Wide-field fundus photograph of an infant: 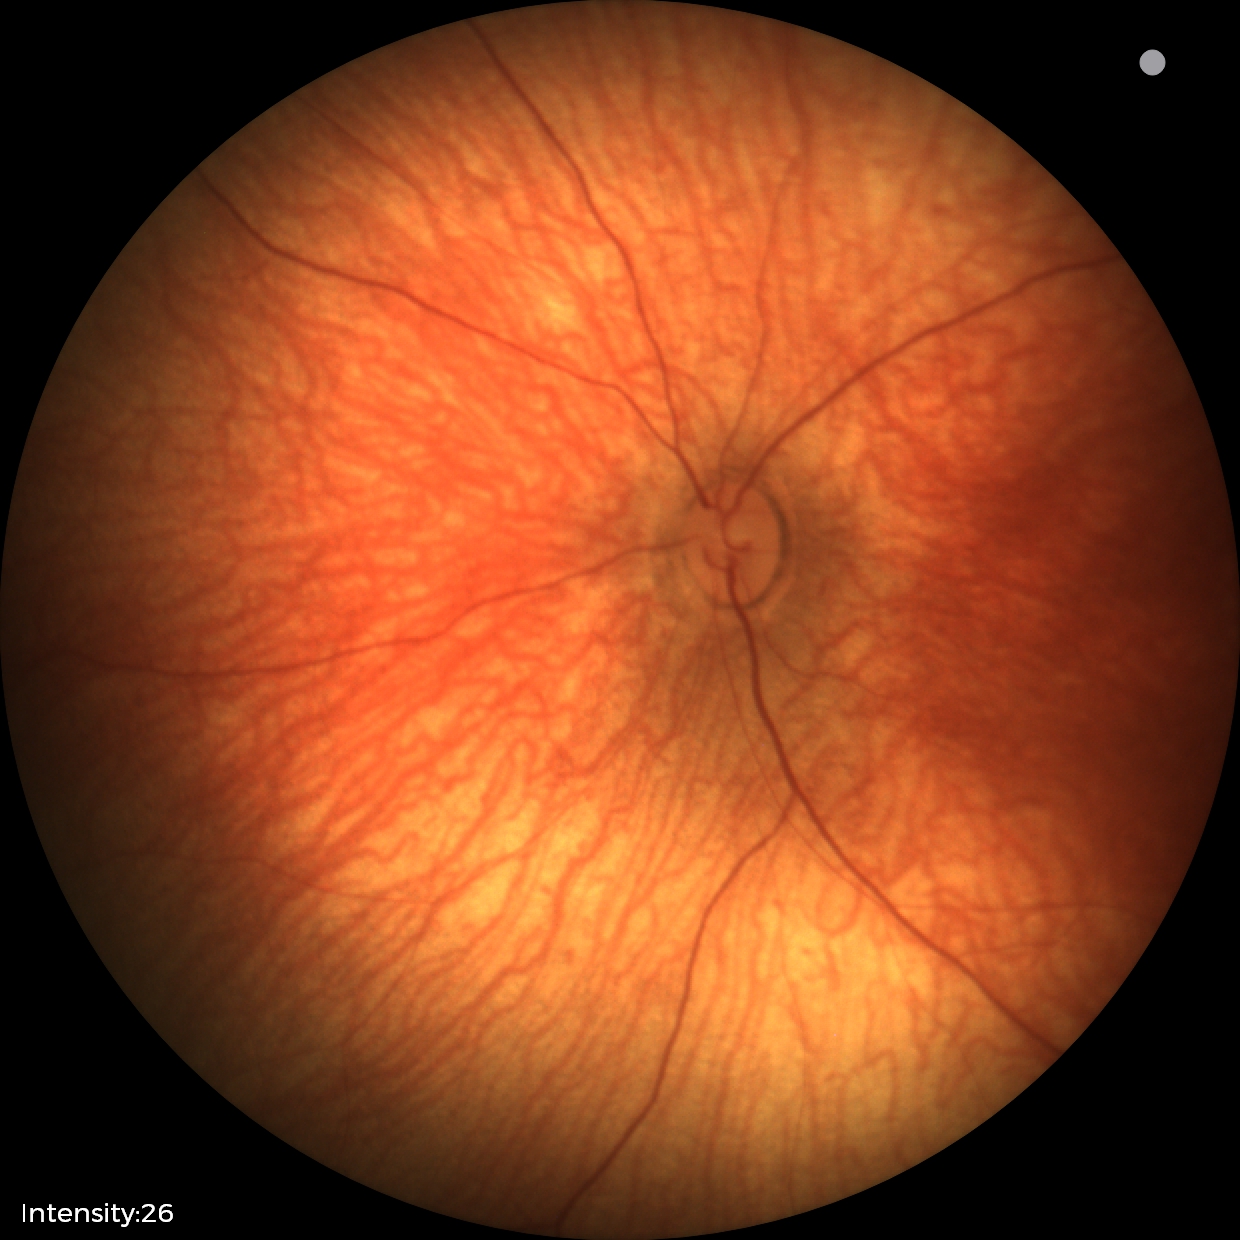
Finding = no abnormalities.